Without pupil dilation — 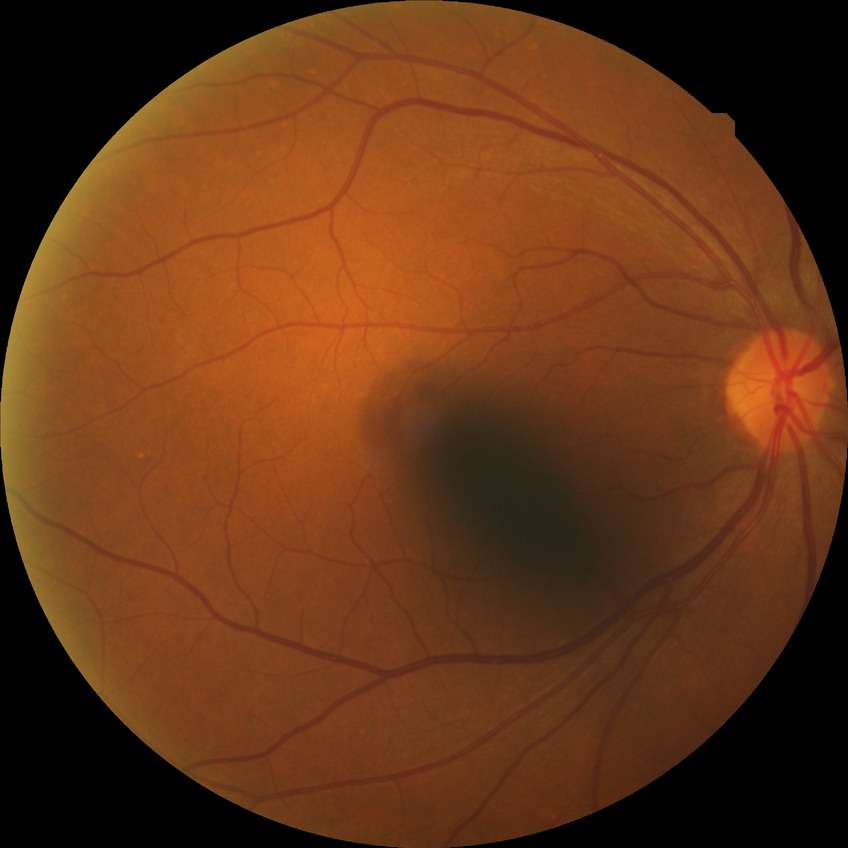

{"dr_impression": "no DR findings", "davis_grade": "NDR"}